Fundus photo.
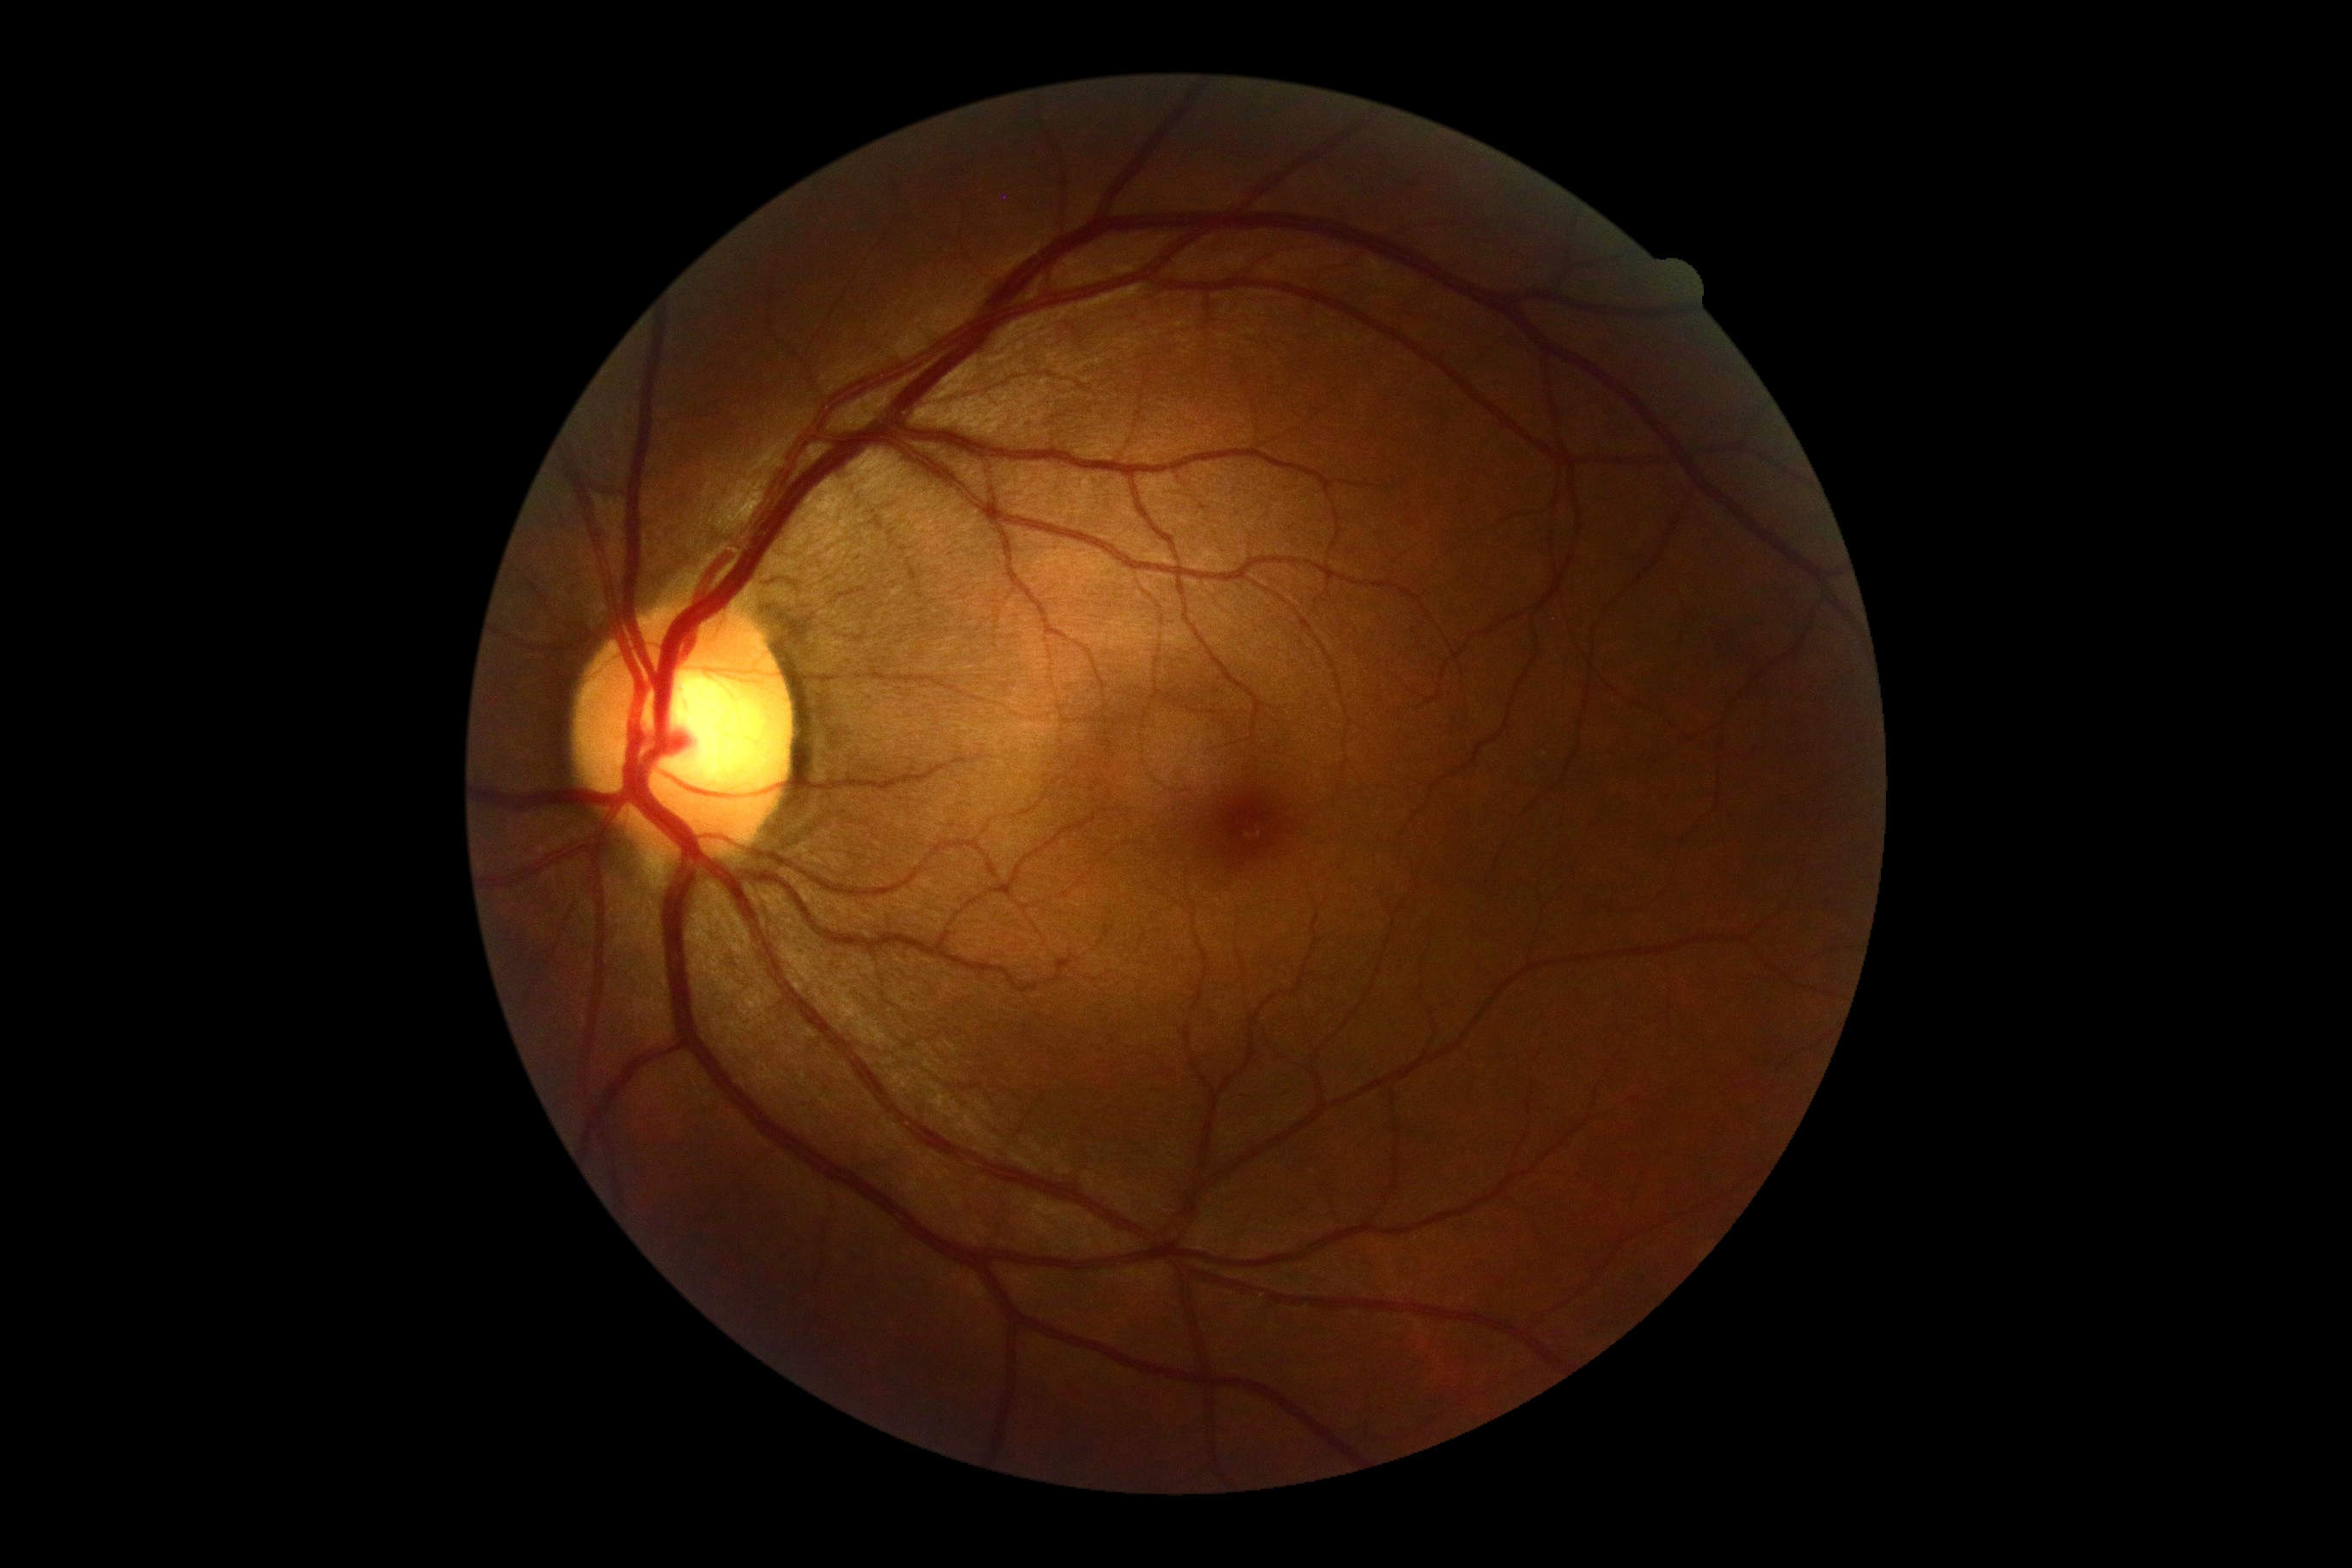
No diabetic retinal disease findings. Diabetic retinopathy (DR) is no apparent diabetic retinopathy (grade 0).